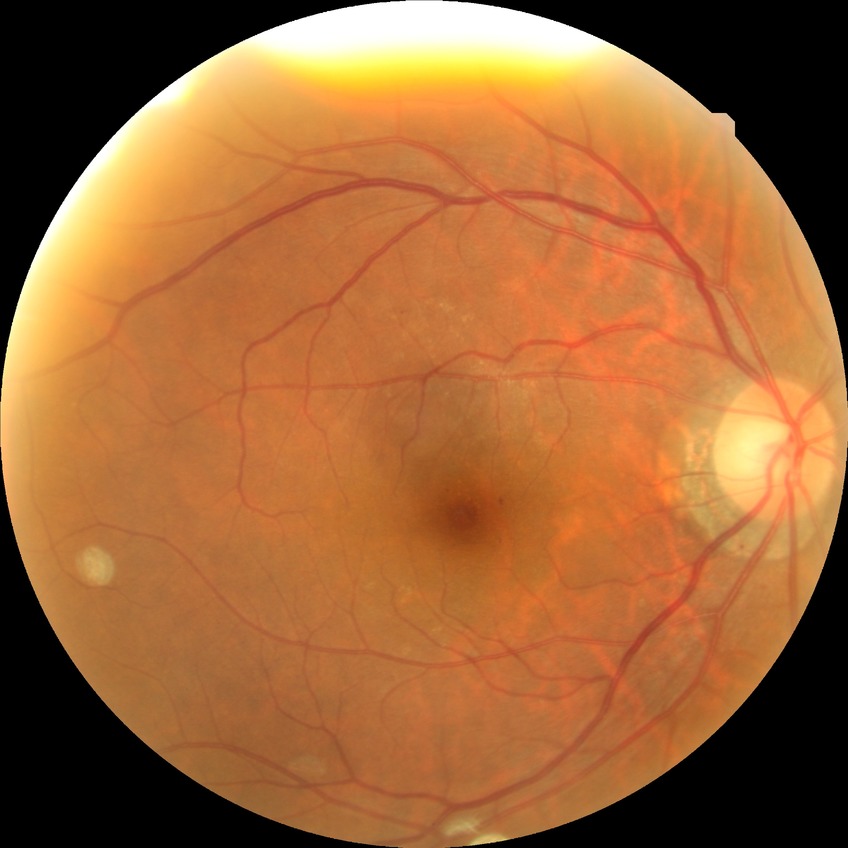

DR is NDR.